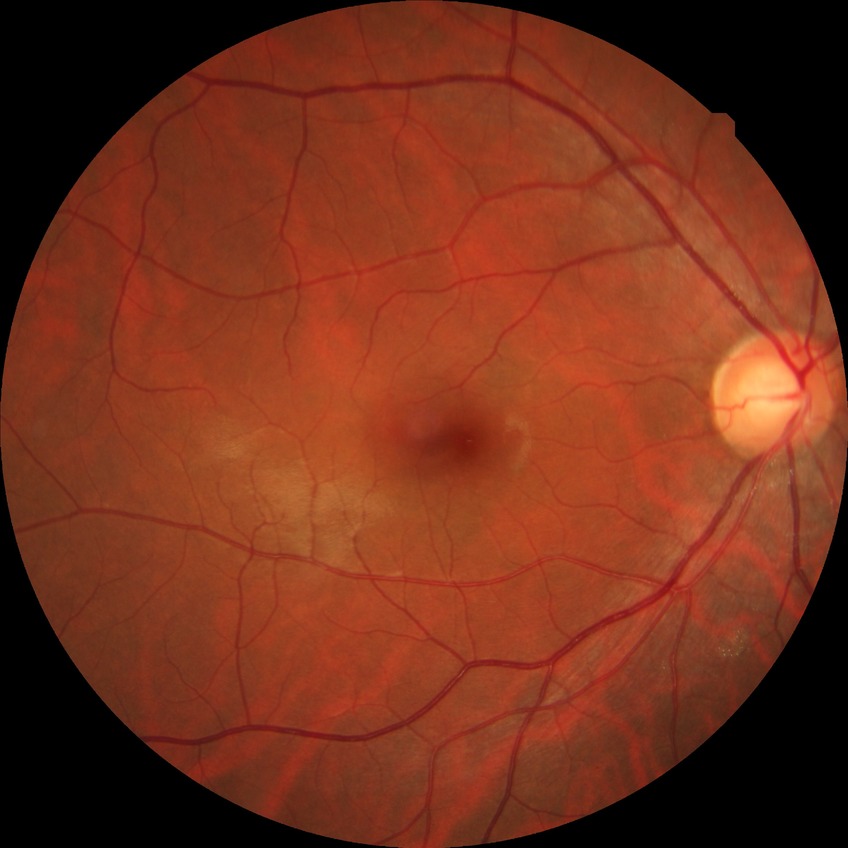 Diabetic retinopathy (DR): no diabetic retinopathy (NDR).